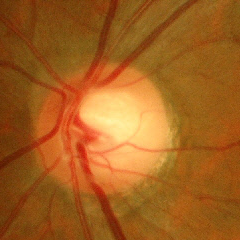 Glaucoma assessment = no glaucoma.